Davis DR grading, FOV: 45 degrees.
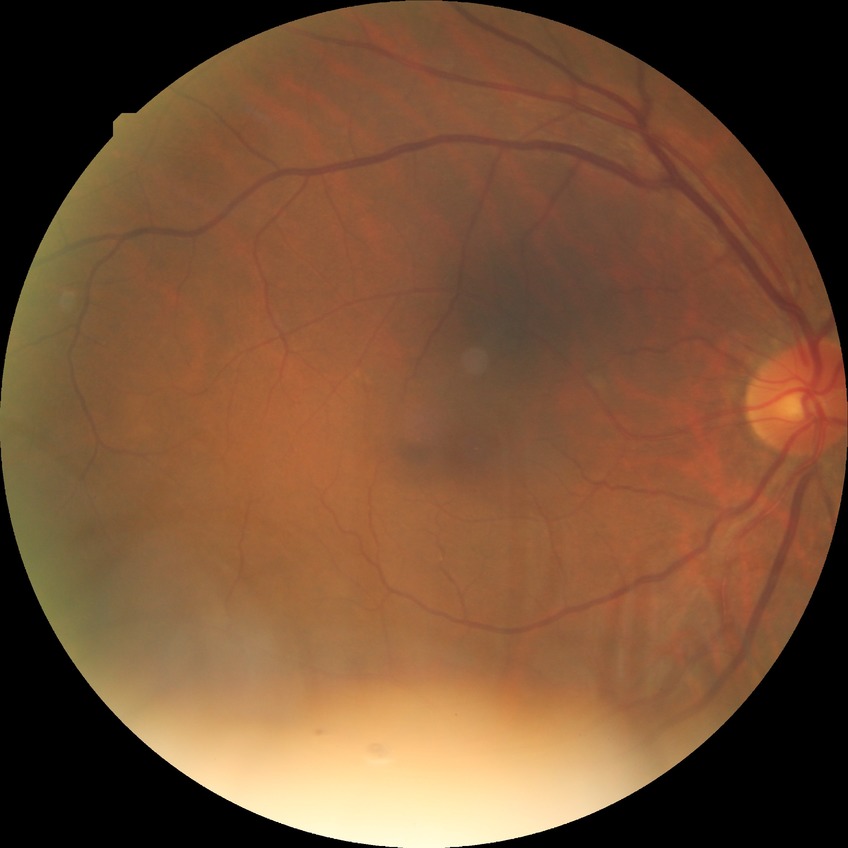

modified Davis grading=simple diabetic retinopathy.